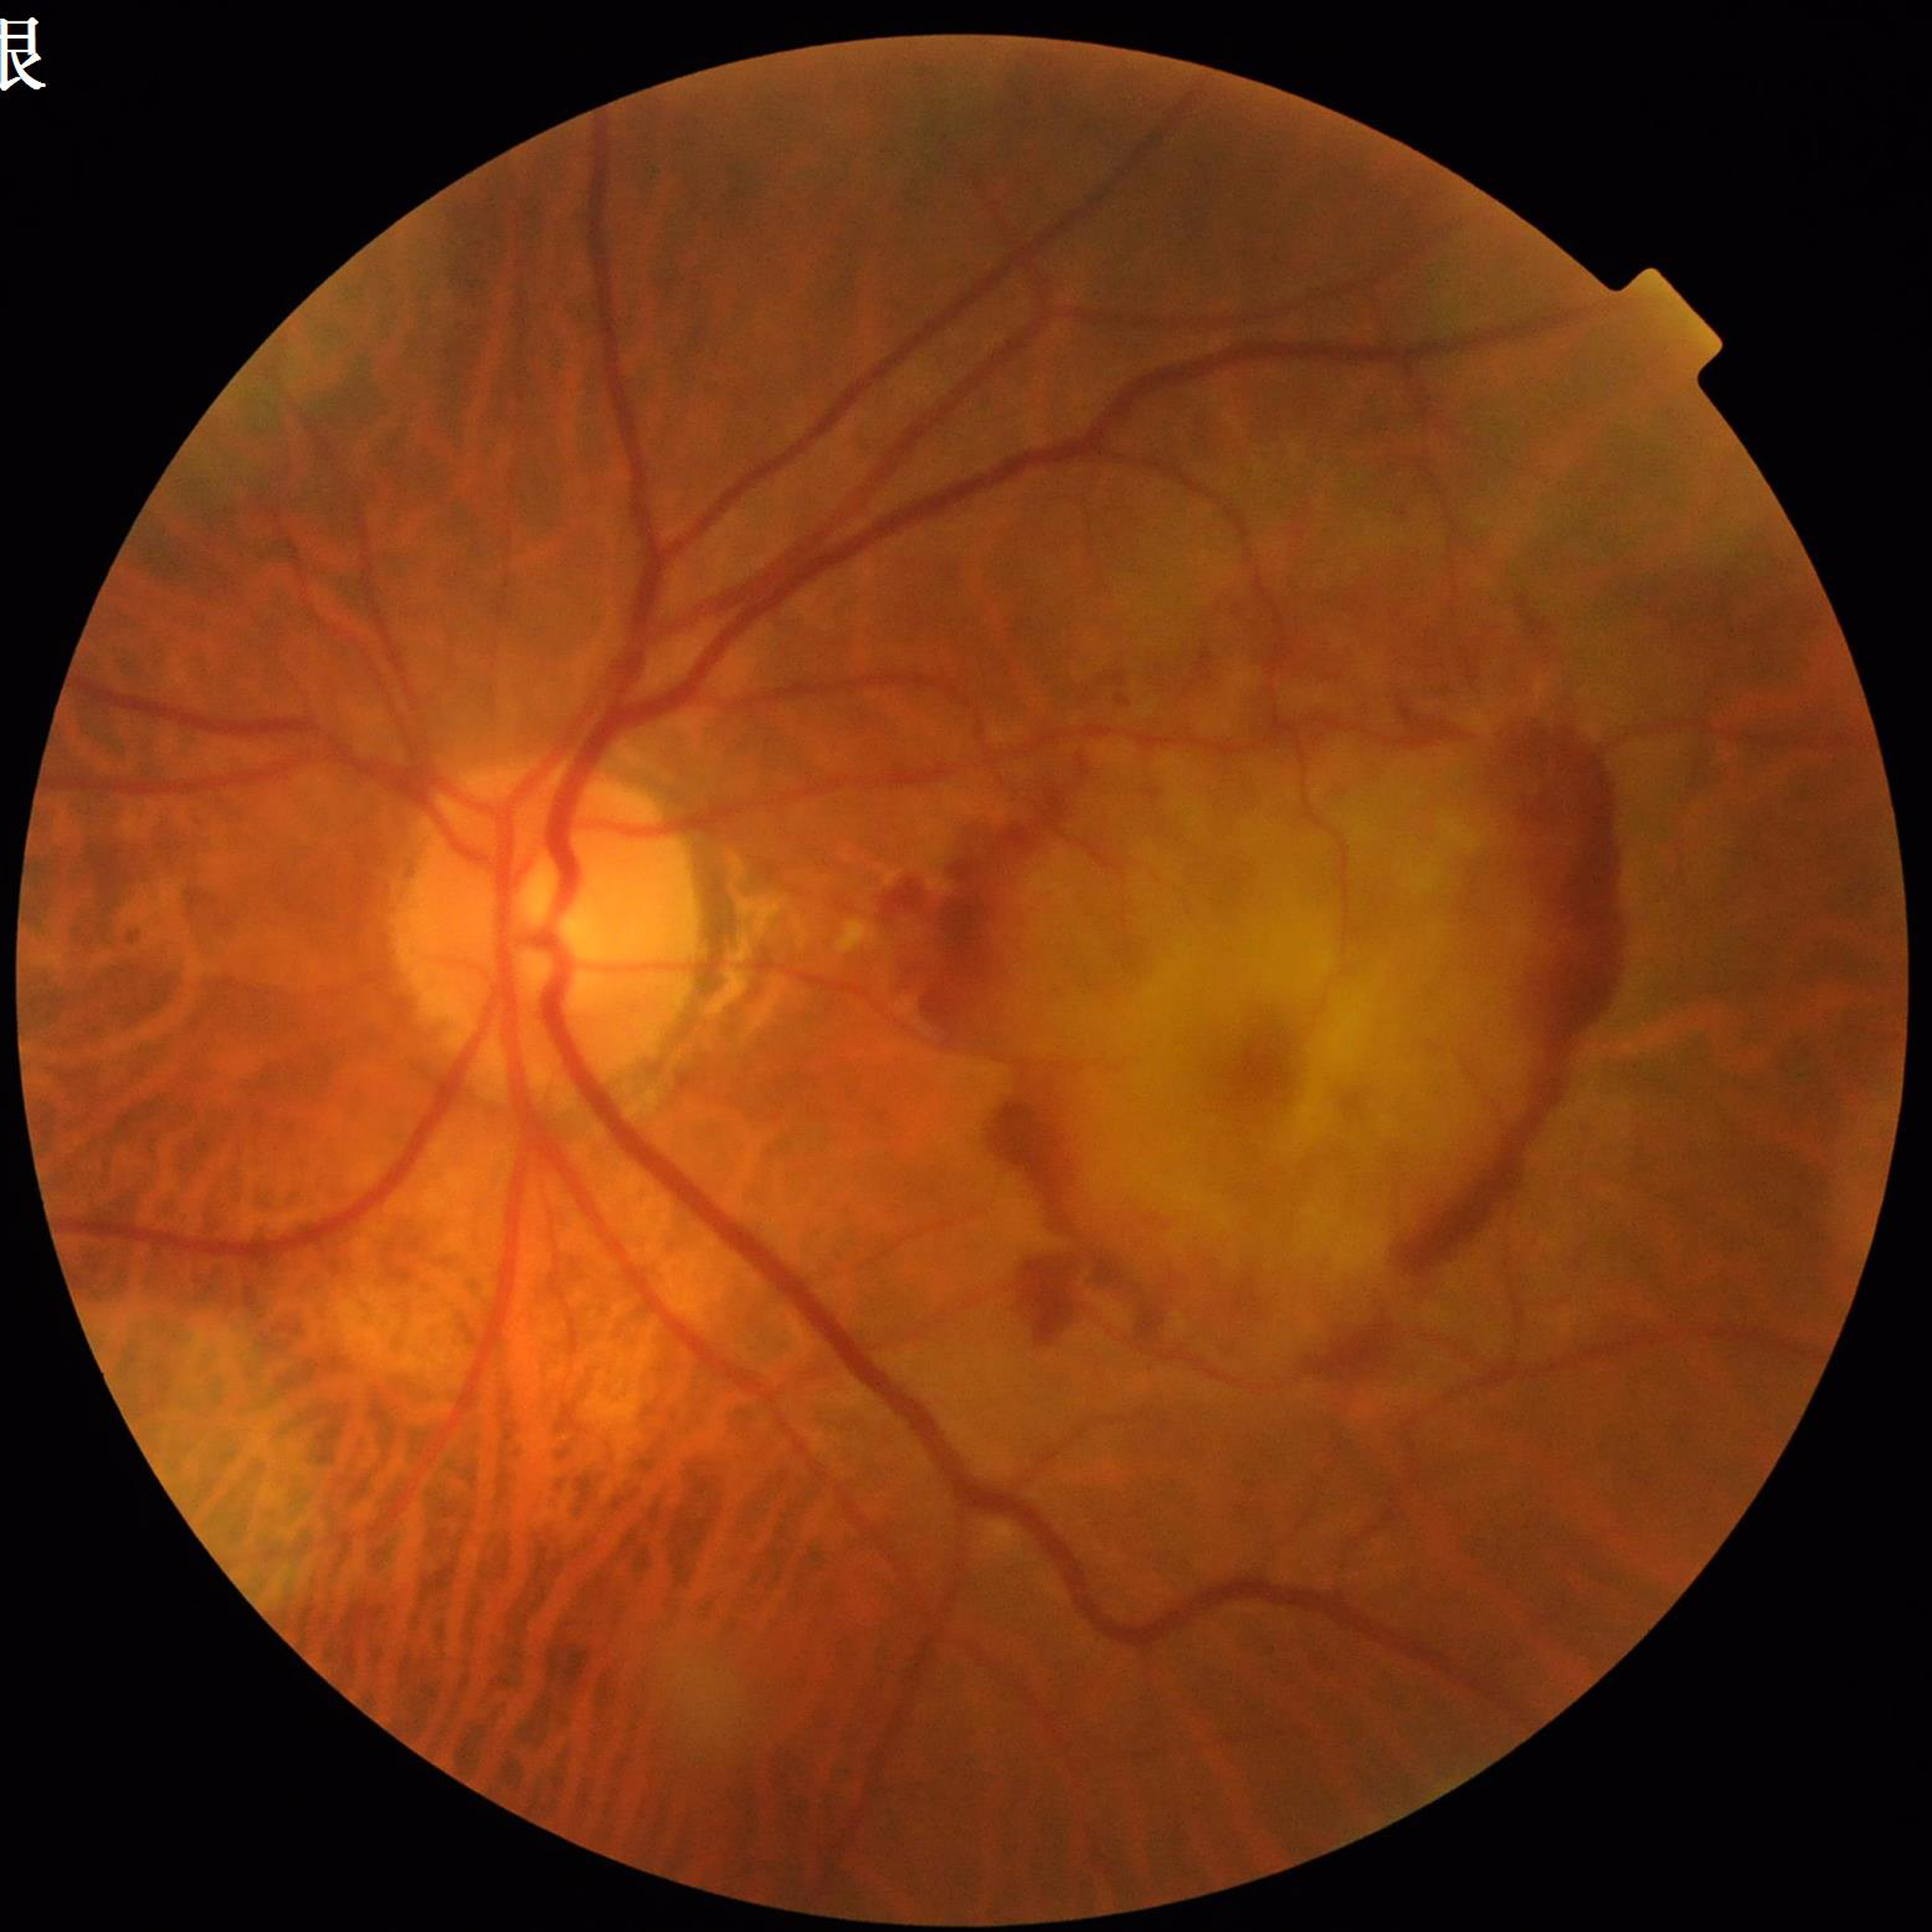

Clinical diagnosis = age-related macular degeneration (AMD).